45° FOV, color fundus photograph
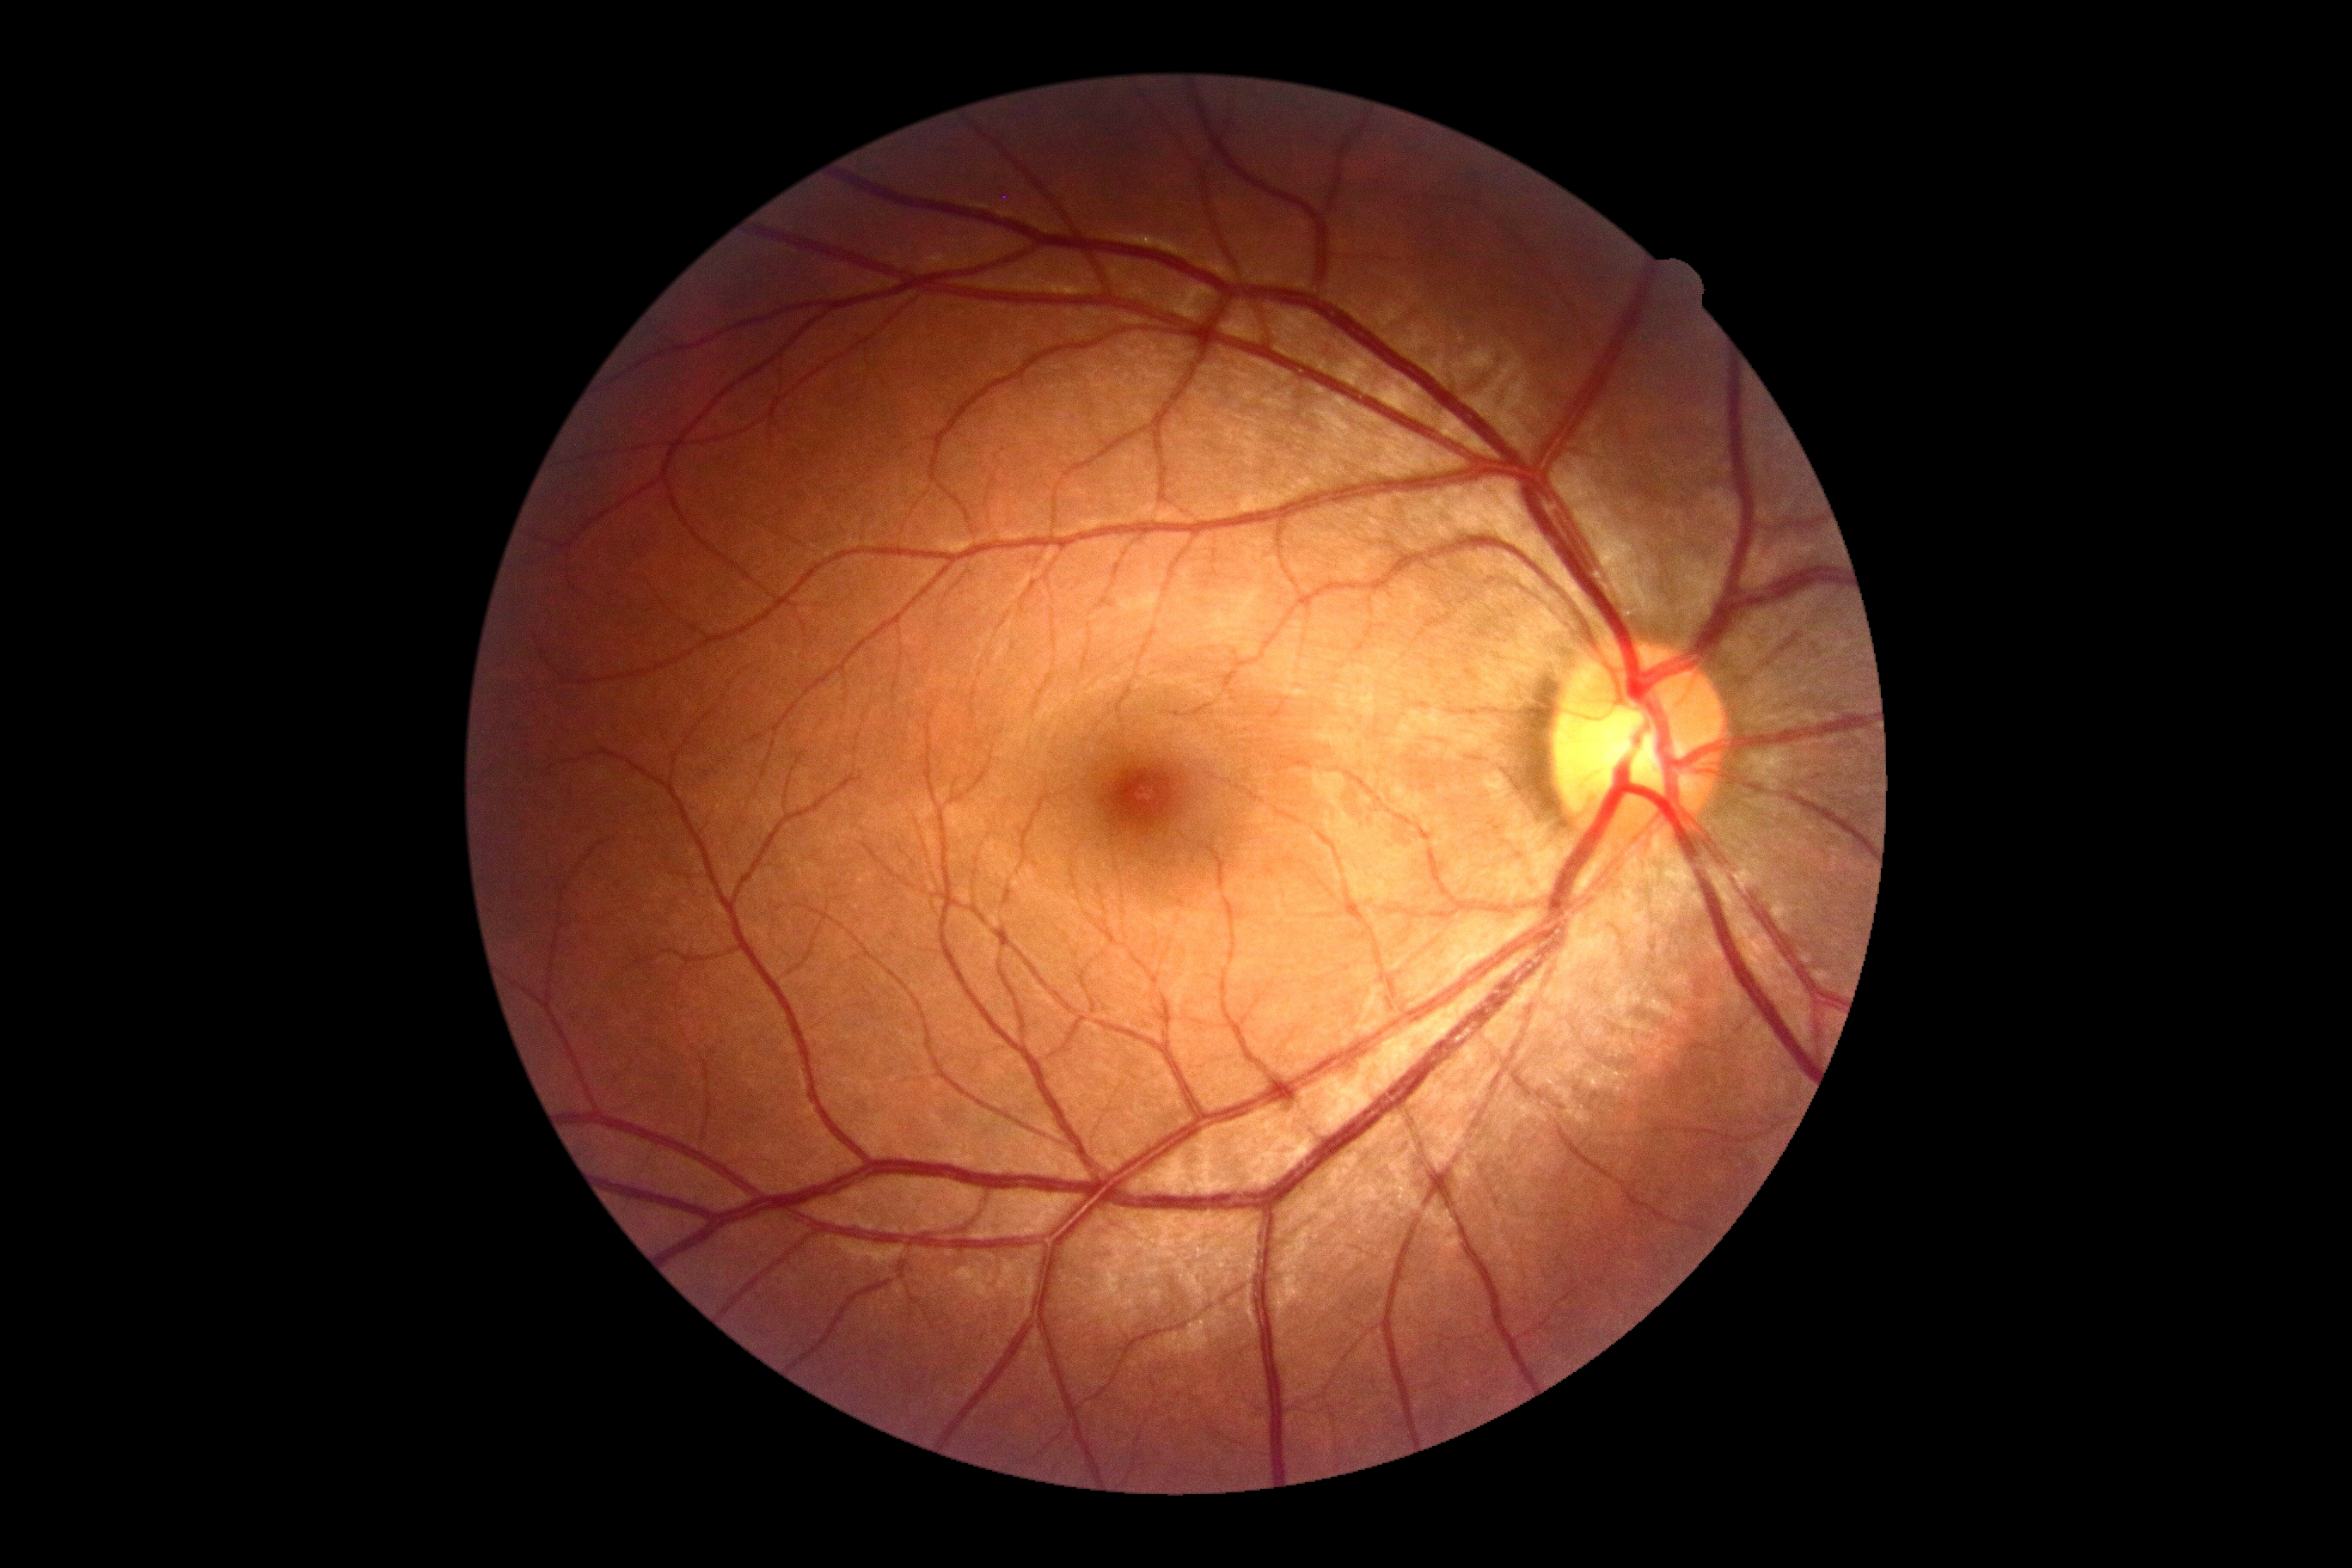
Retinopathy grade is 0 (no apparent retinopathy).
No DR findings.